Camera: NIDEK AFC-230
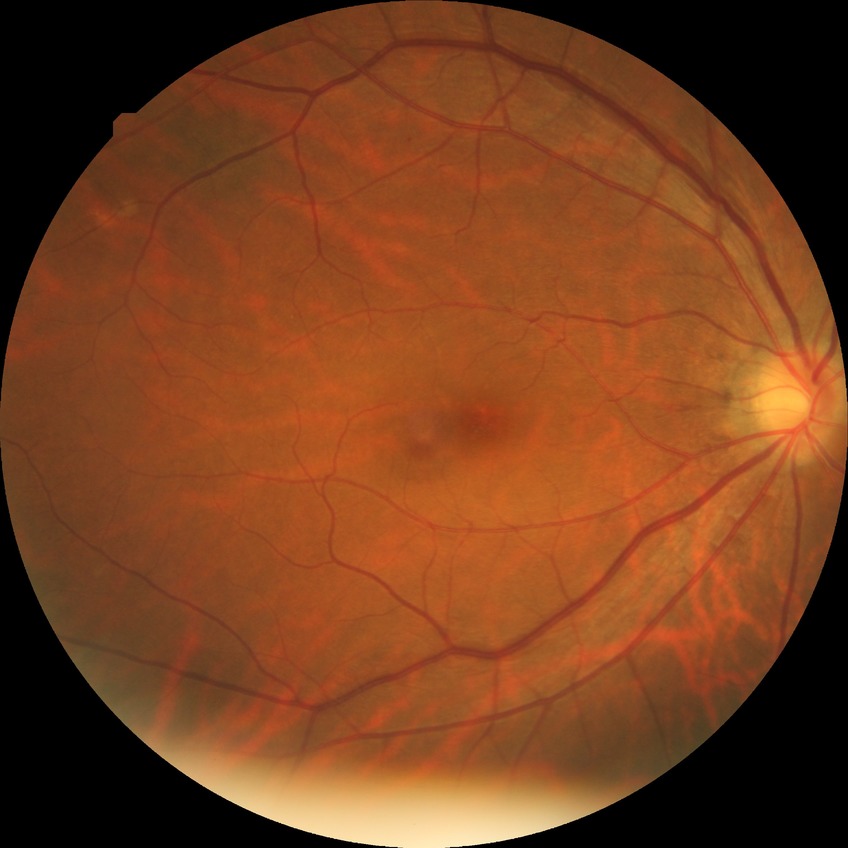 Retinopathy grade: no diabetic retinopathy.